45° field of view. 2352x1568px. Color fundus photograph
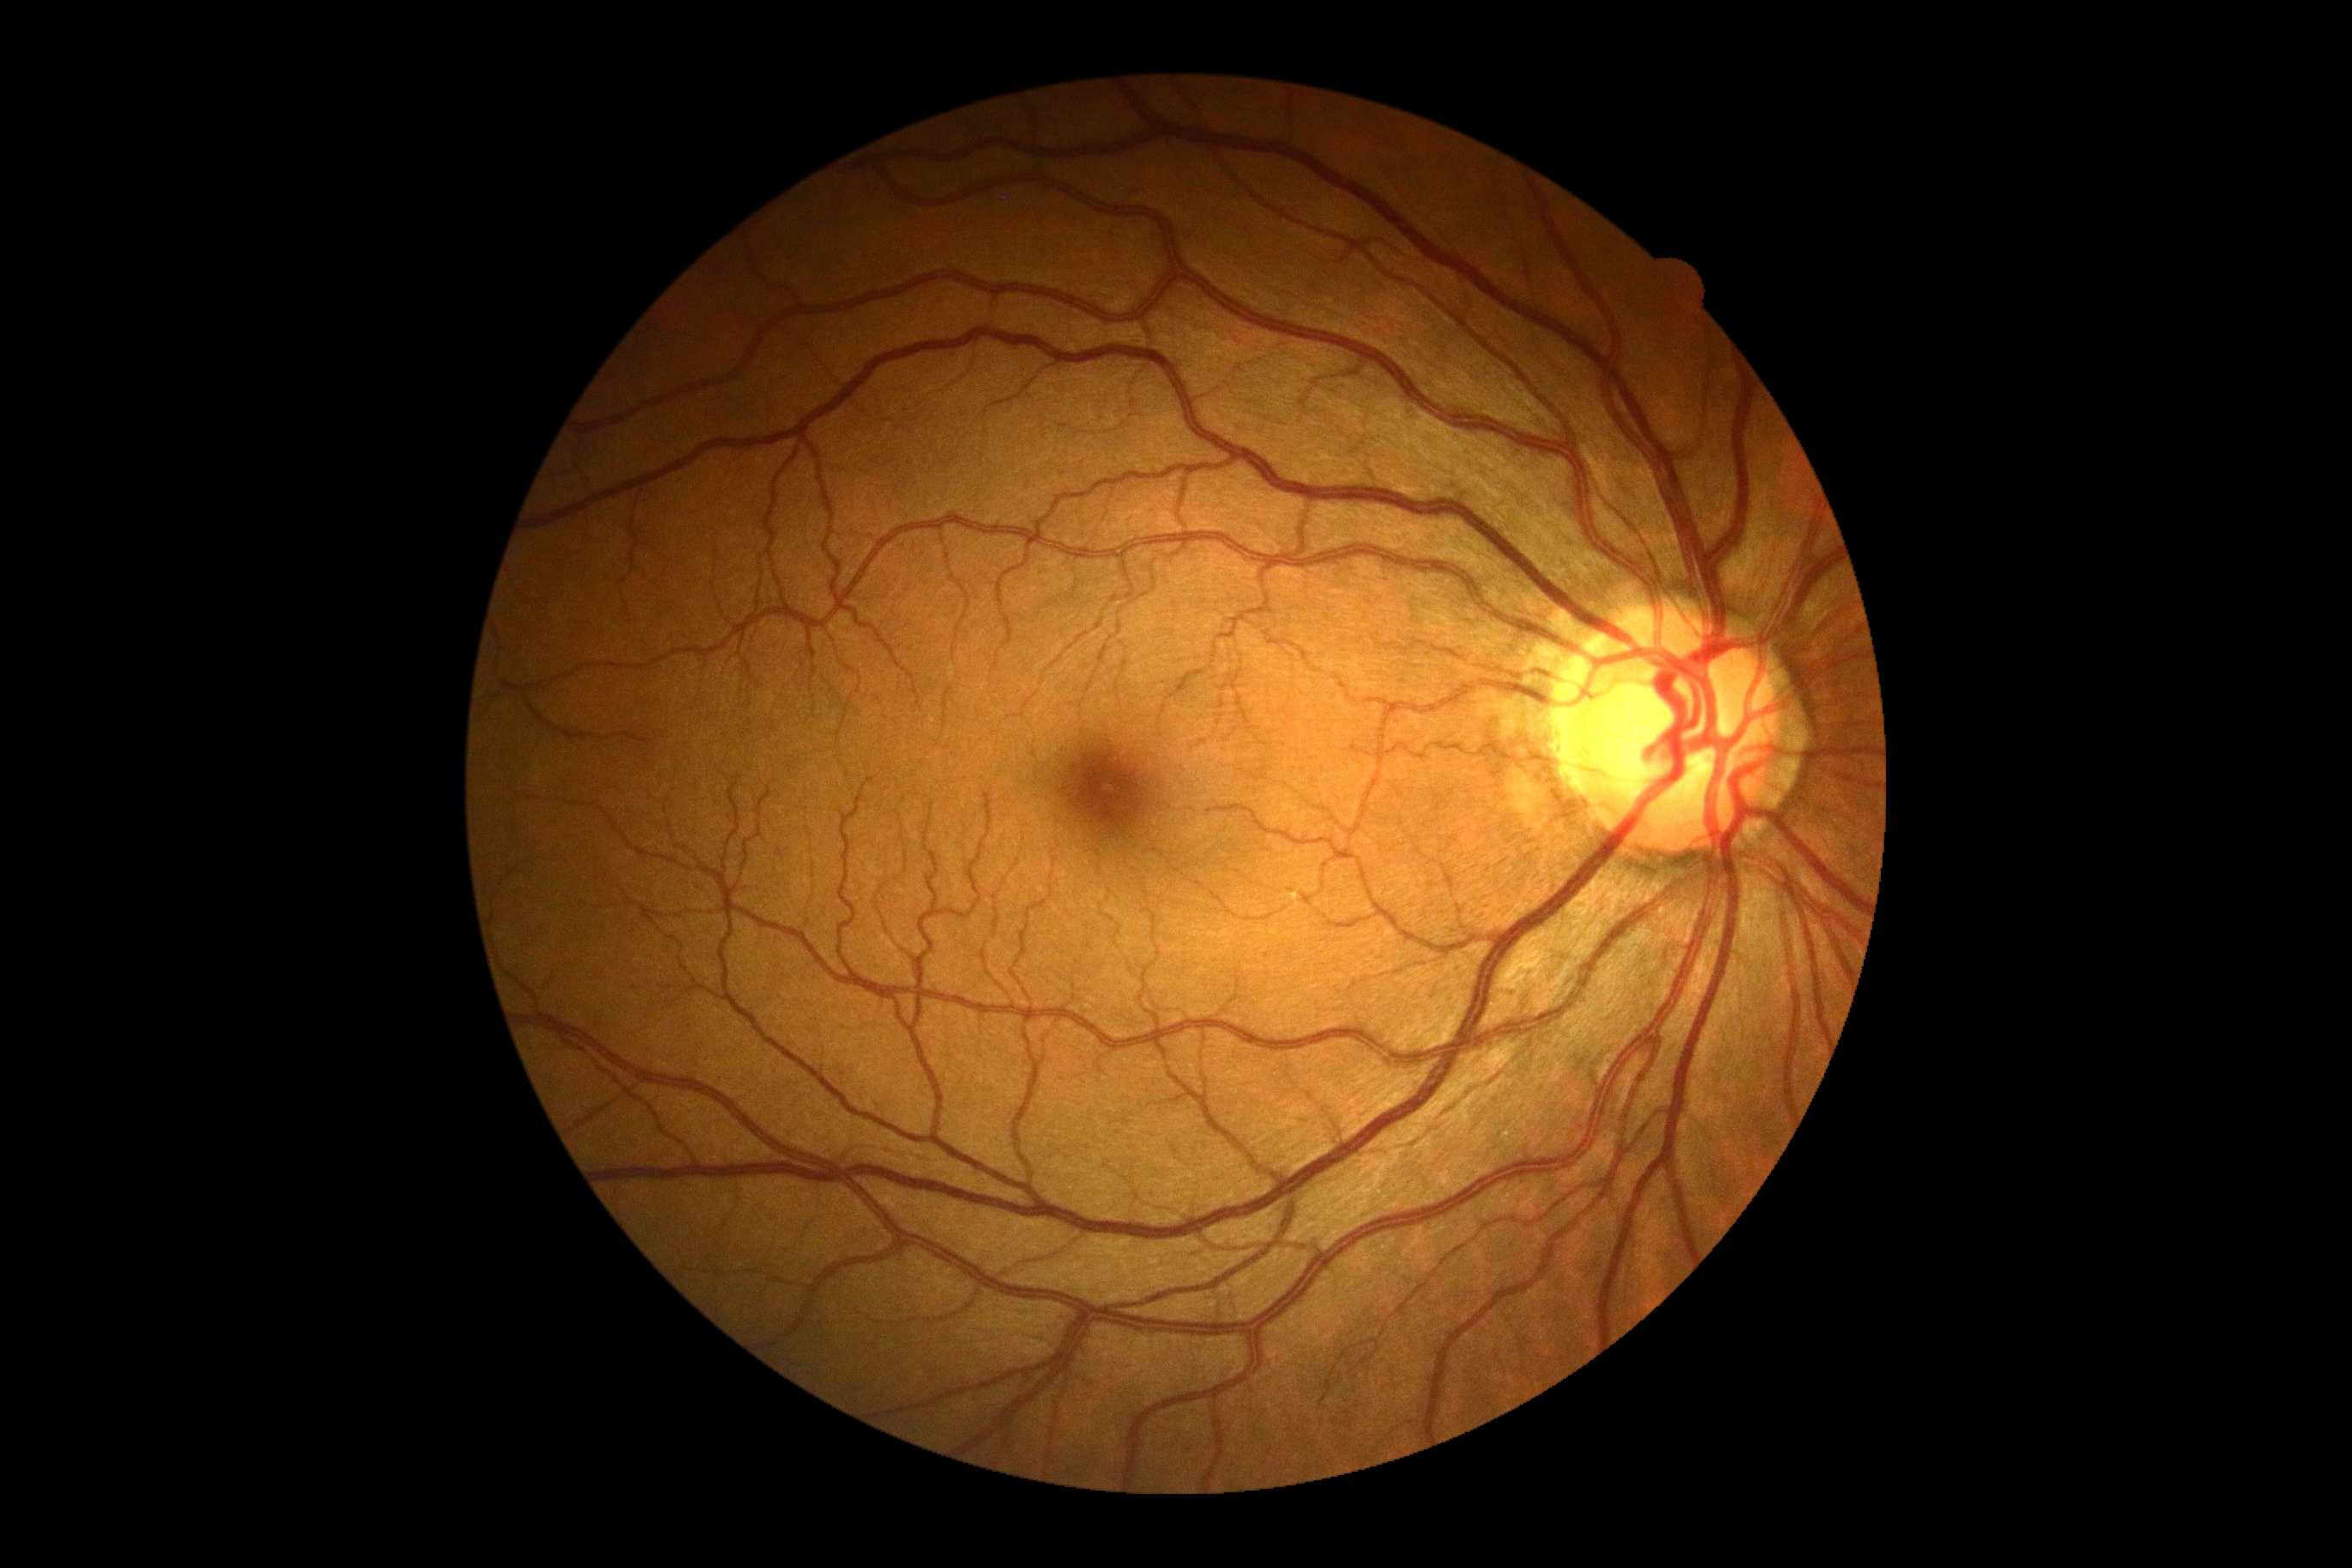 DR impression: no DR findings
diabetic retinopathy: no apparent diabetic retinopathy (grade 0)